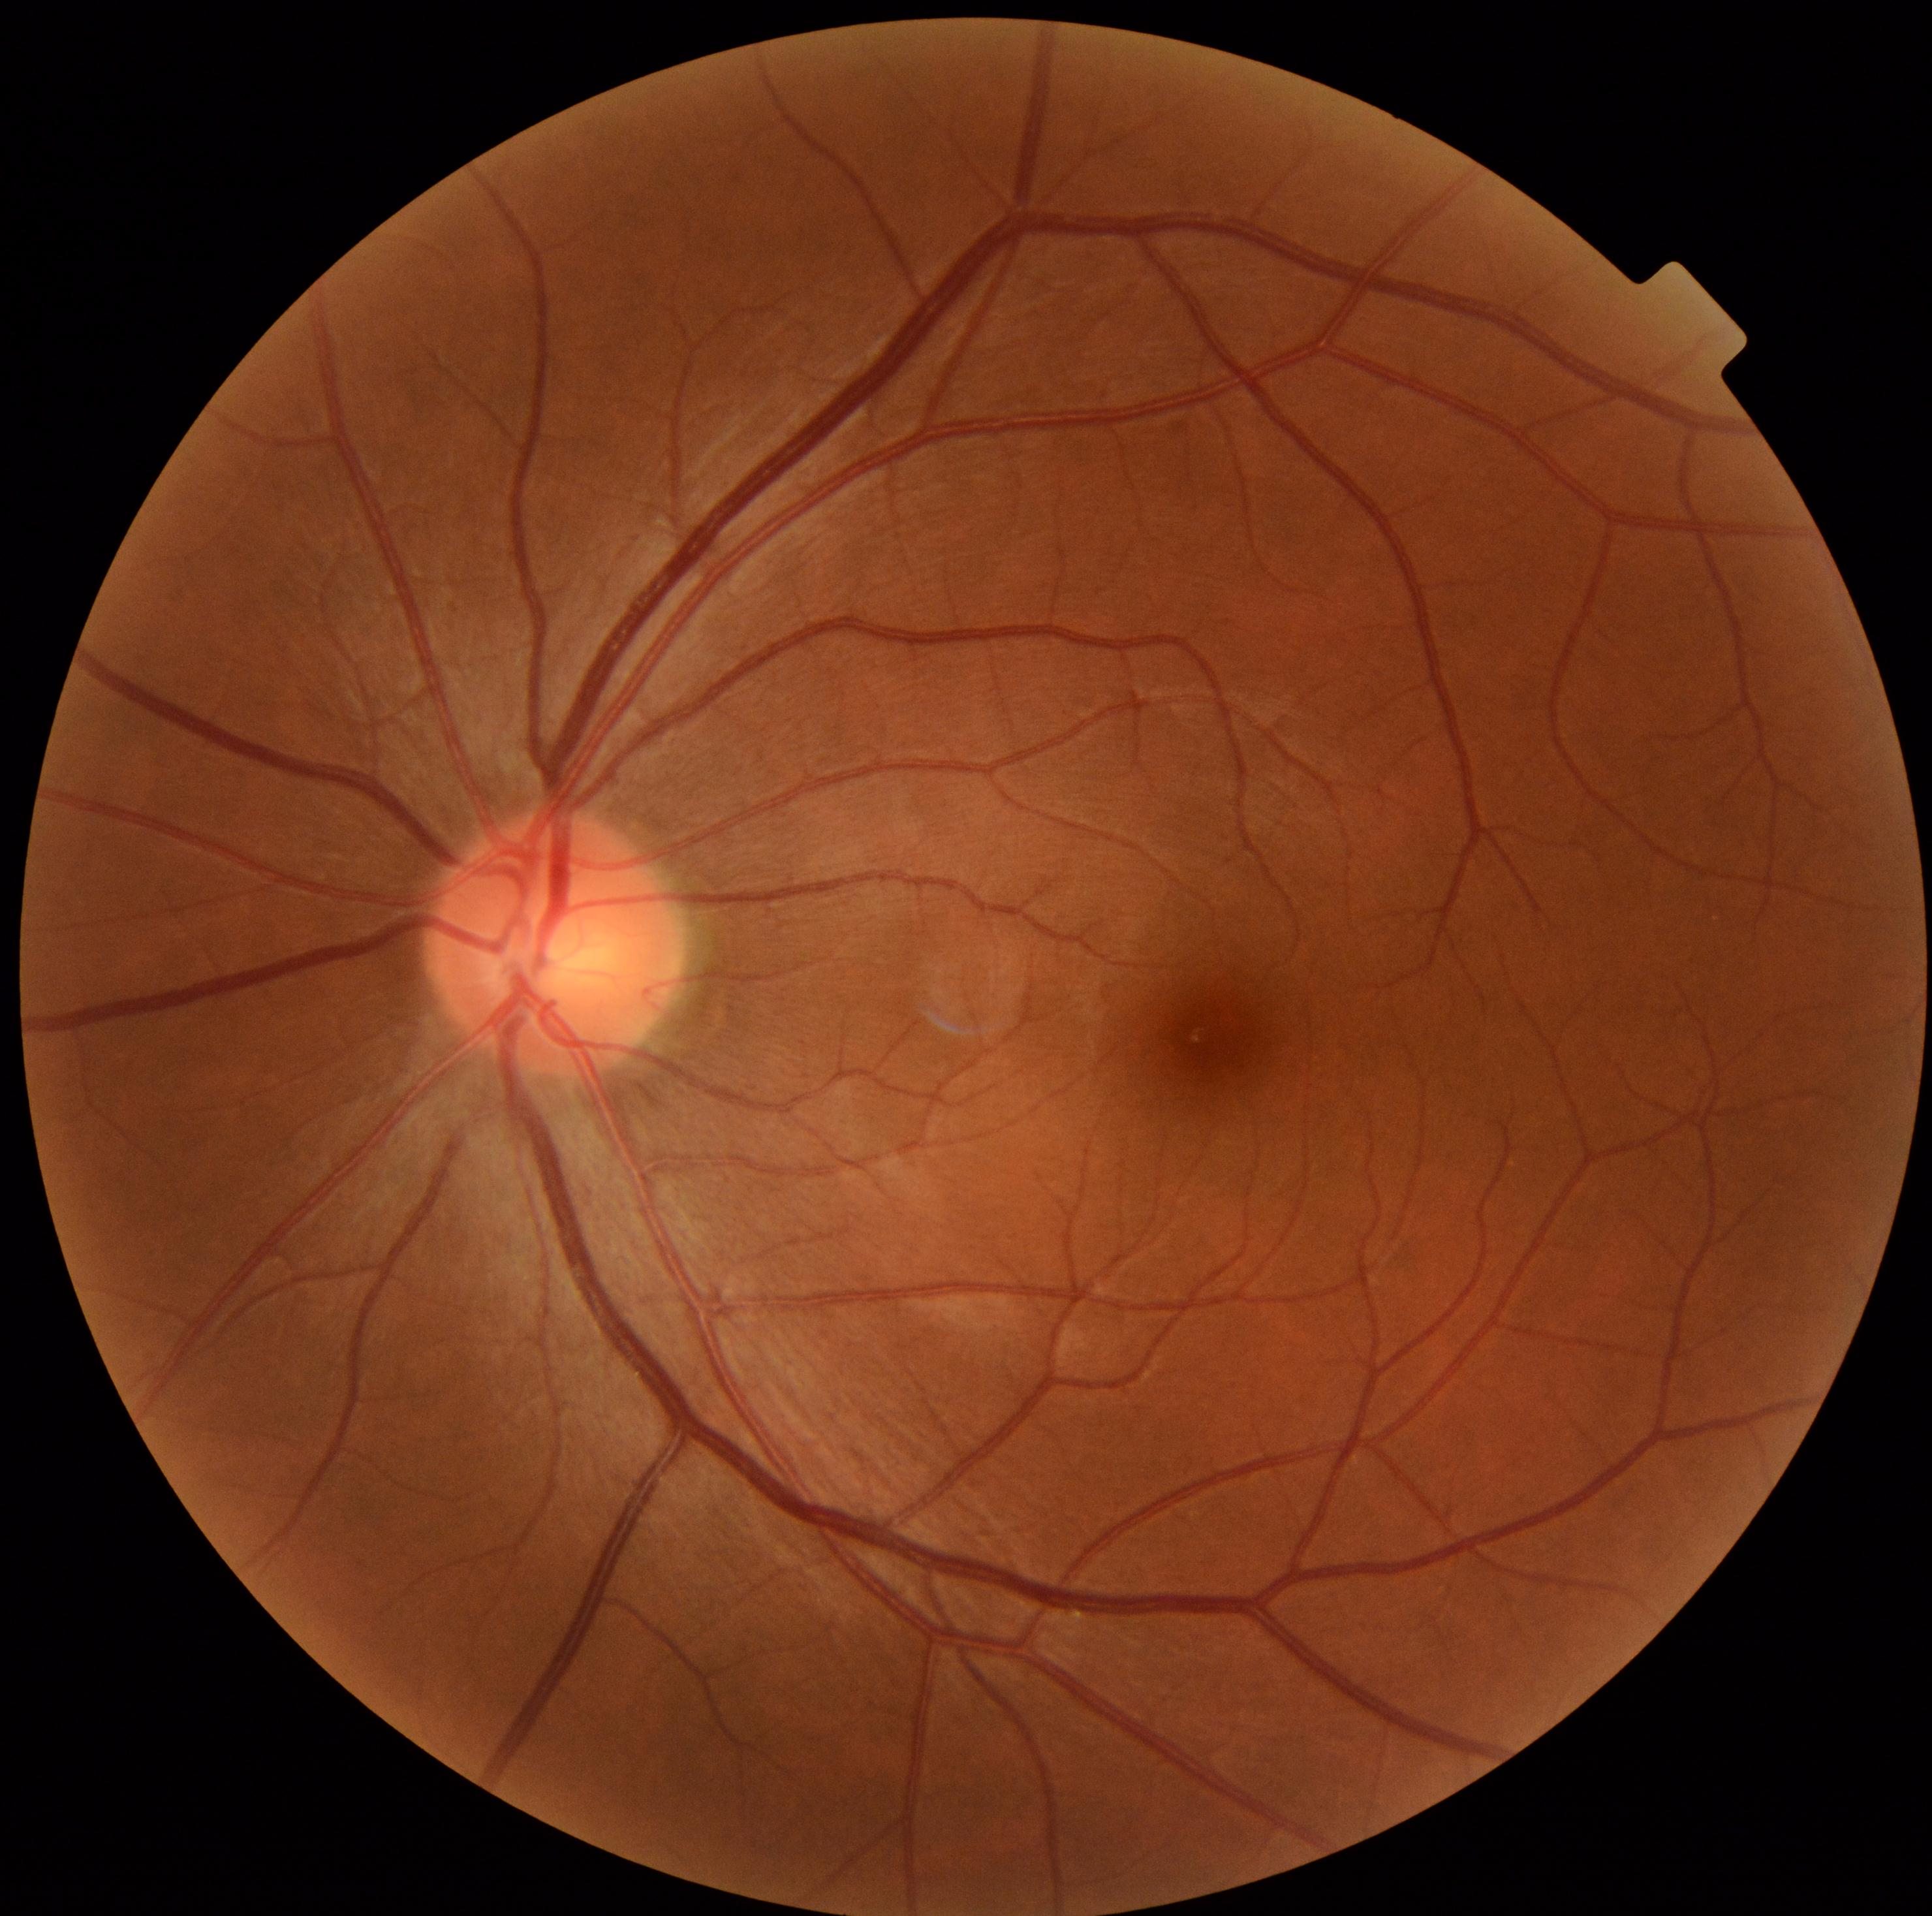
* diabetic retinopathy (DR): grade 0 (no apparent retinopathy) — no visible signs of diabetic retinopathy